64-year-old patient; gender: F; axial length 22.48 mm; FOV: 30 degrees.
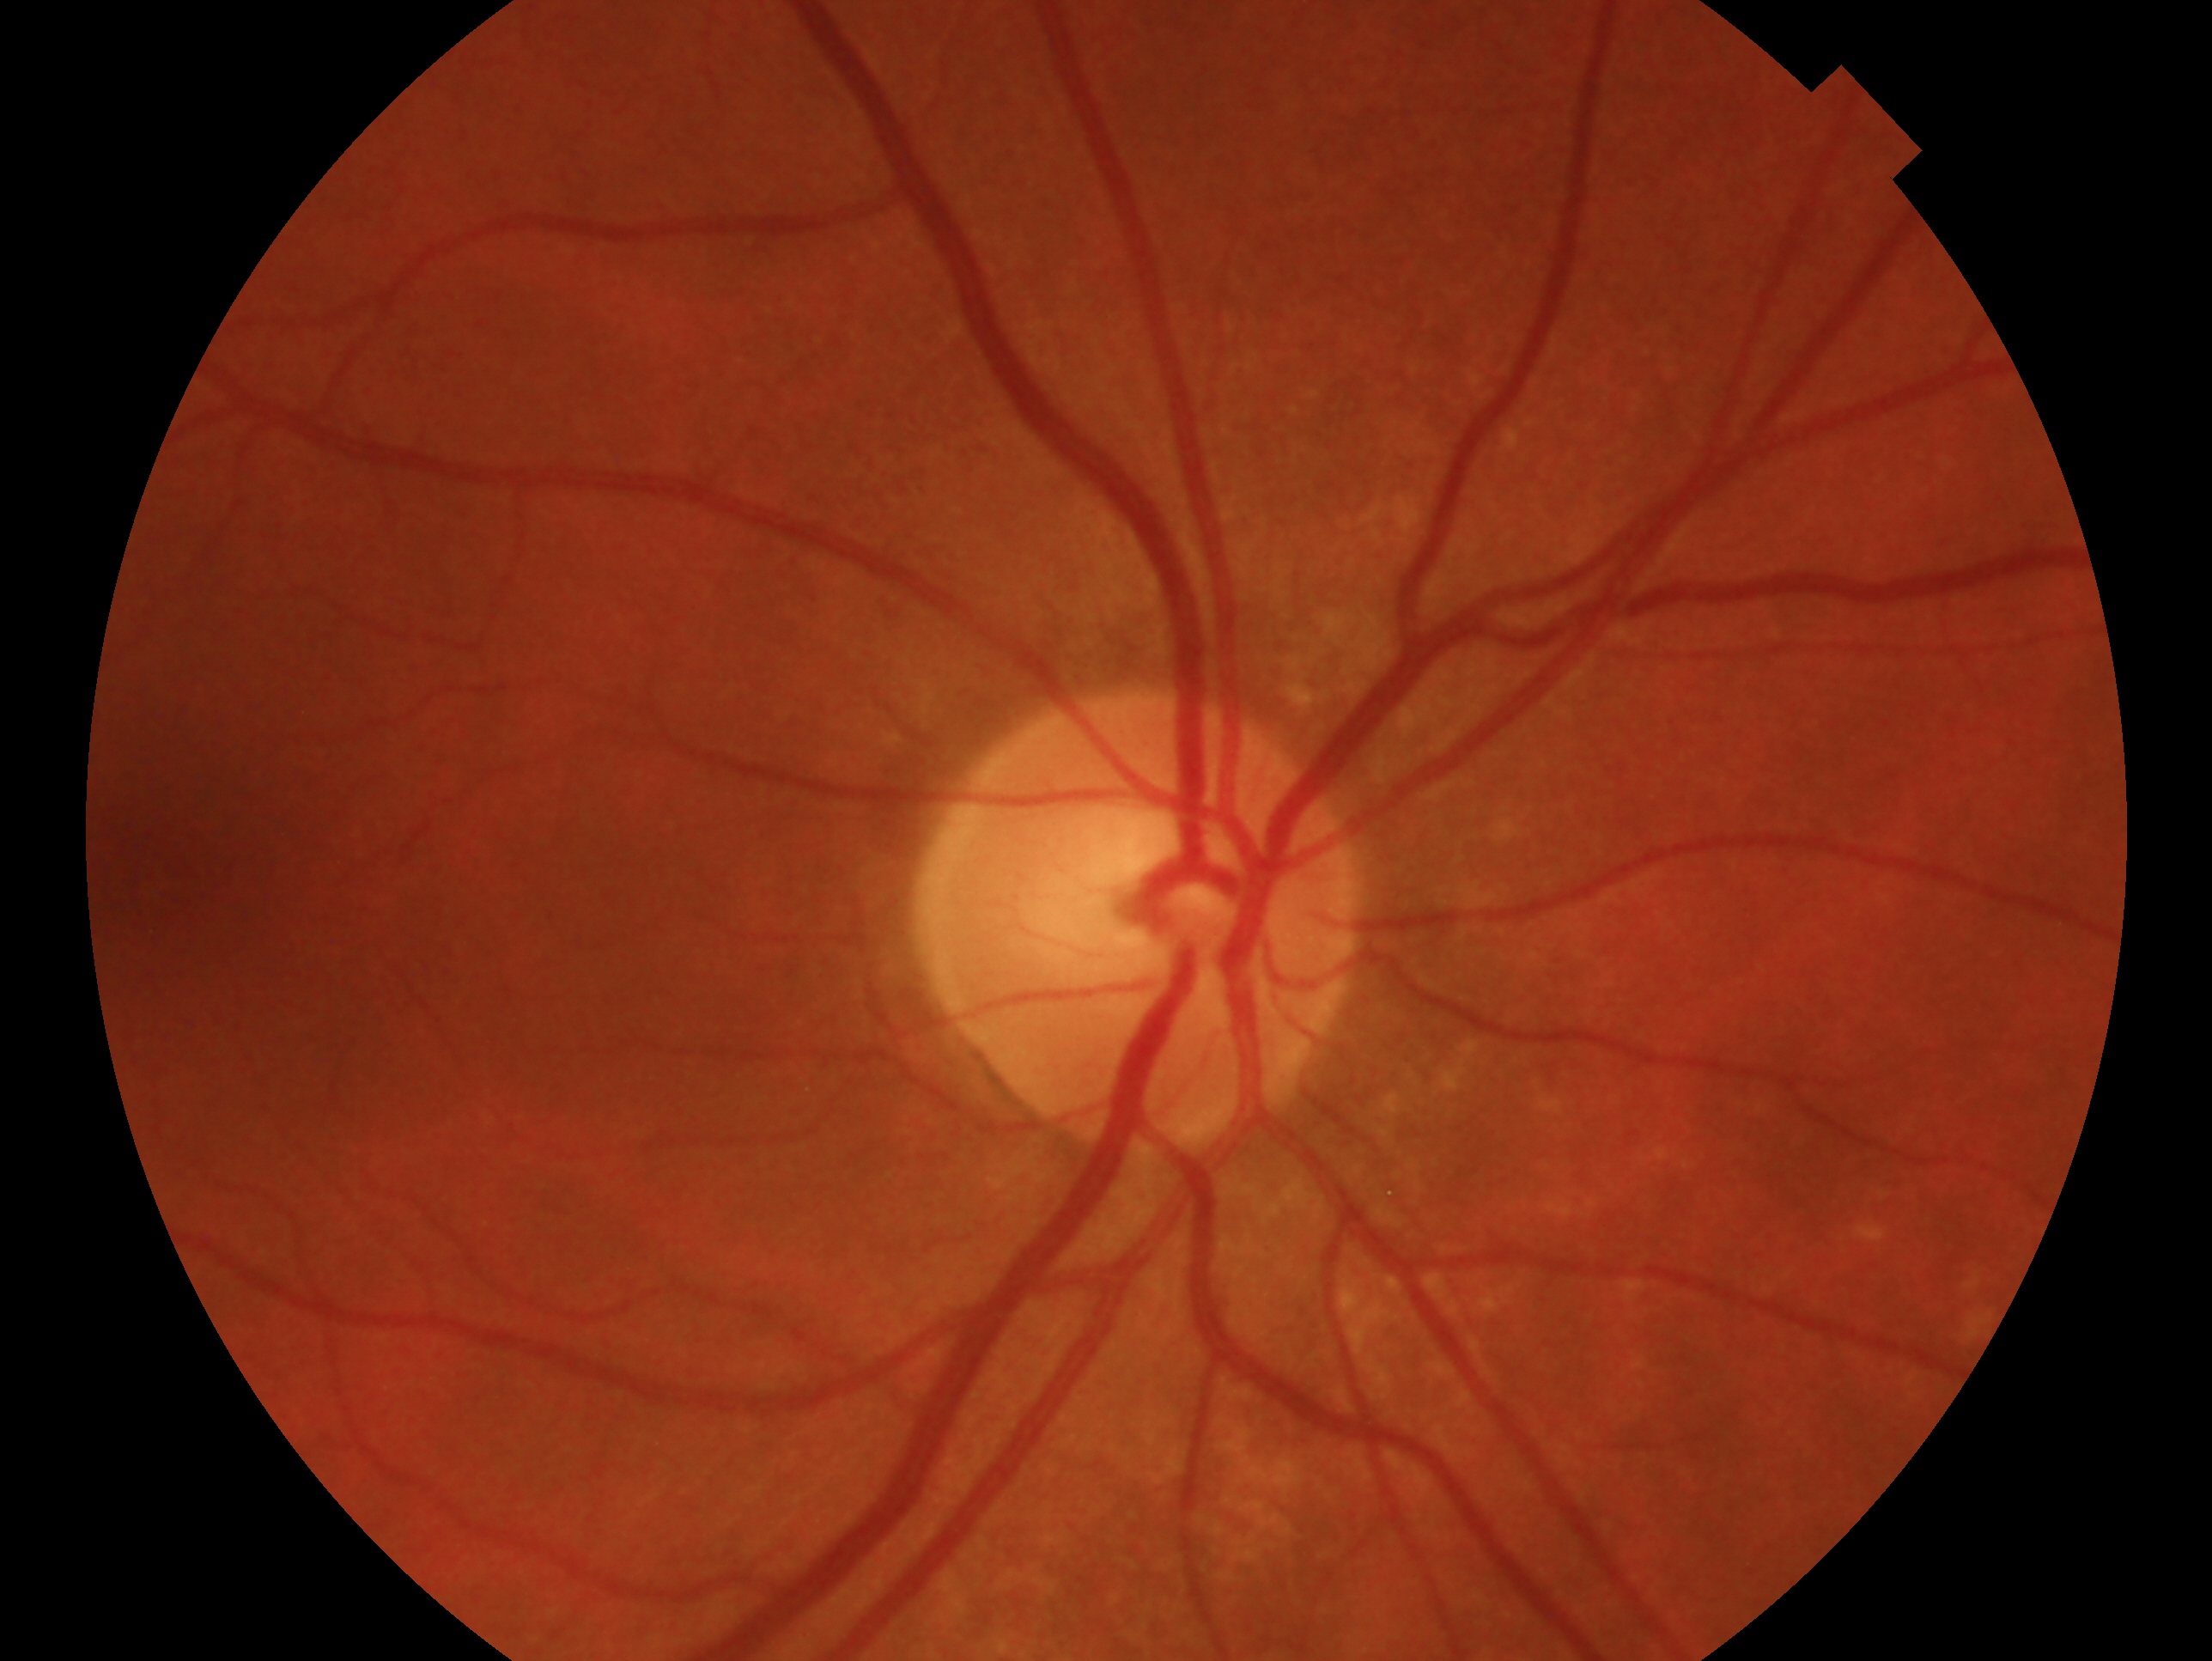

{"glaucoma_dx": "negative for glaucoma", "eye": "right eye"}